Wide-field contact fundus photograph of an infant: 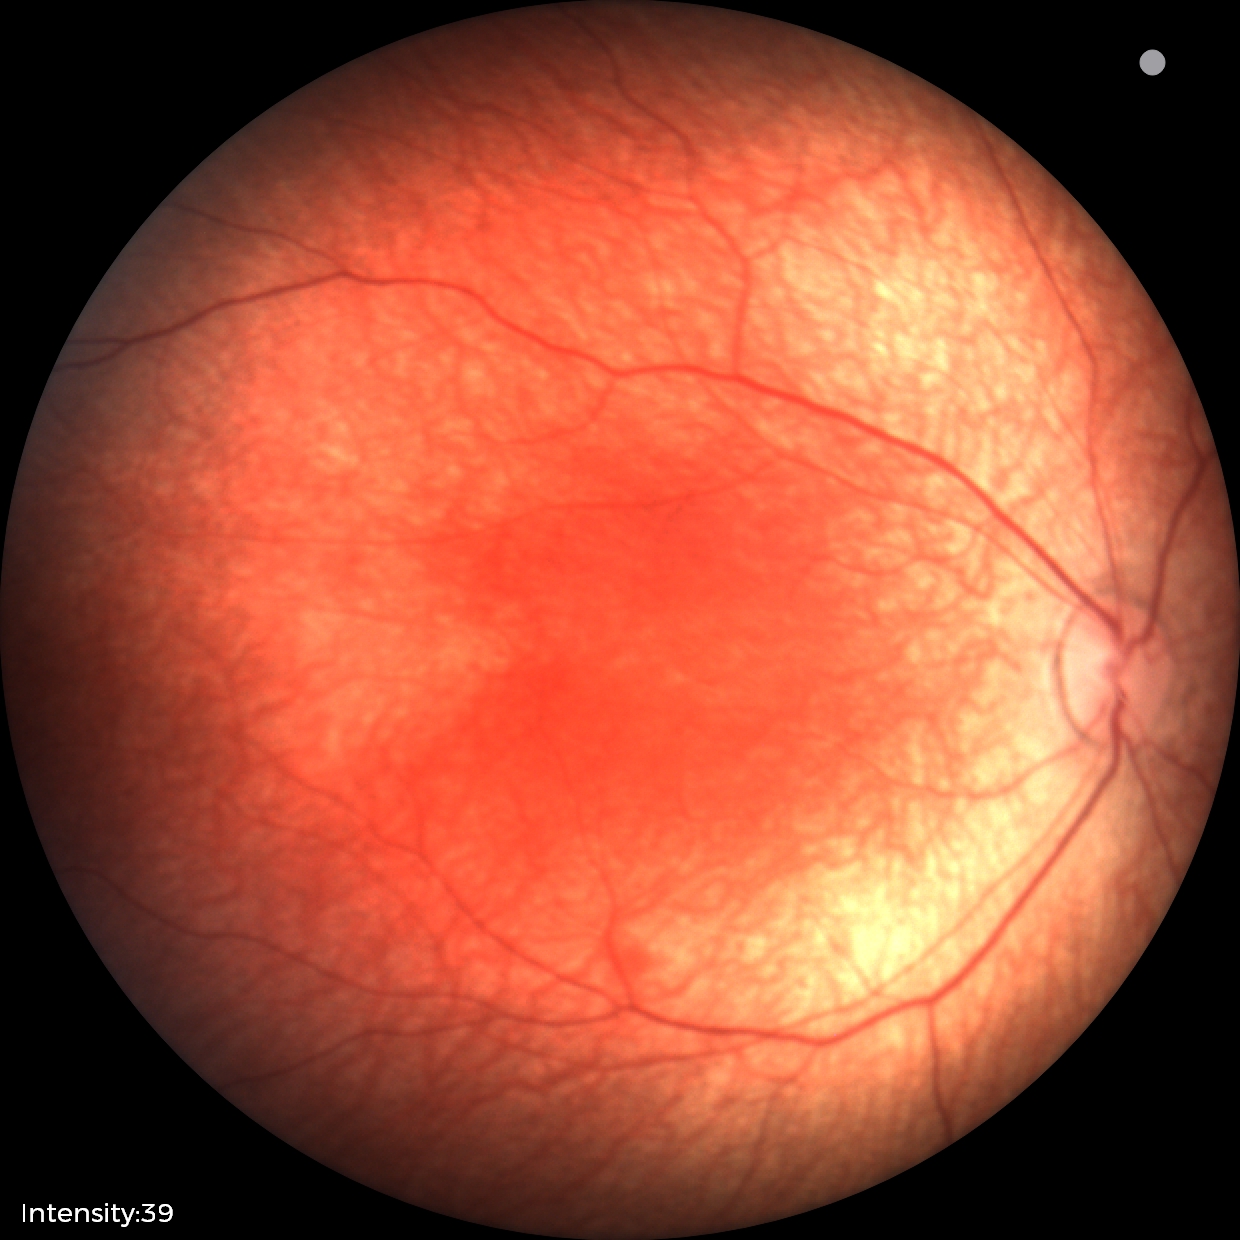

Impression = physiological.